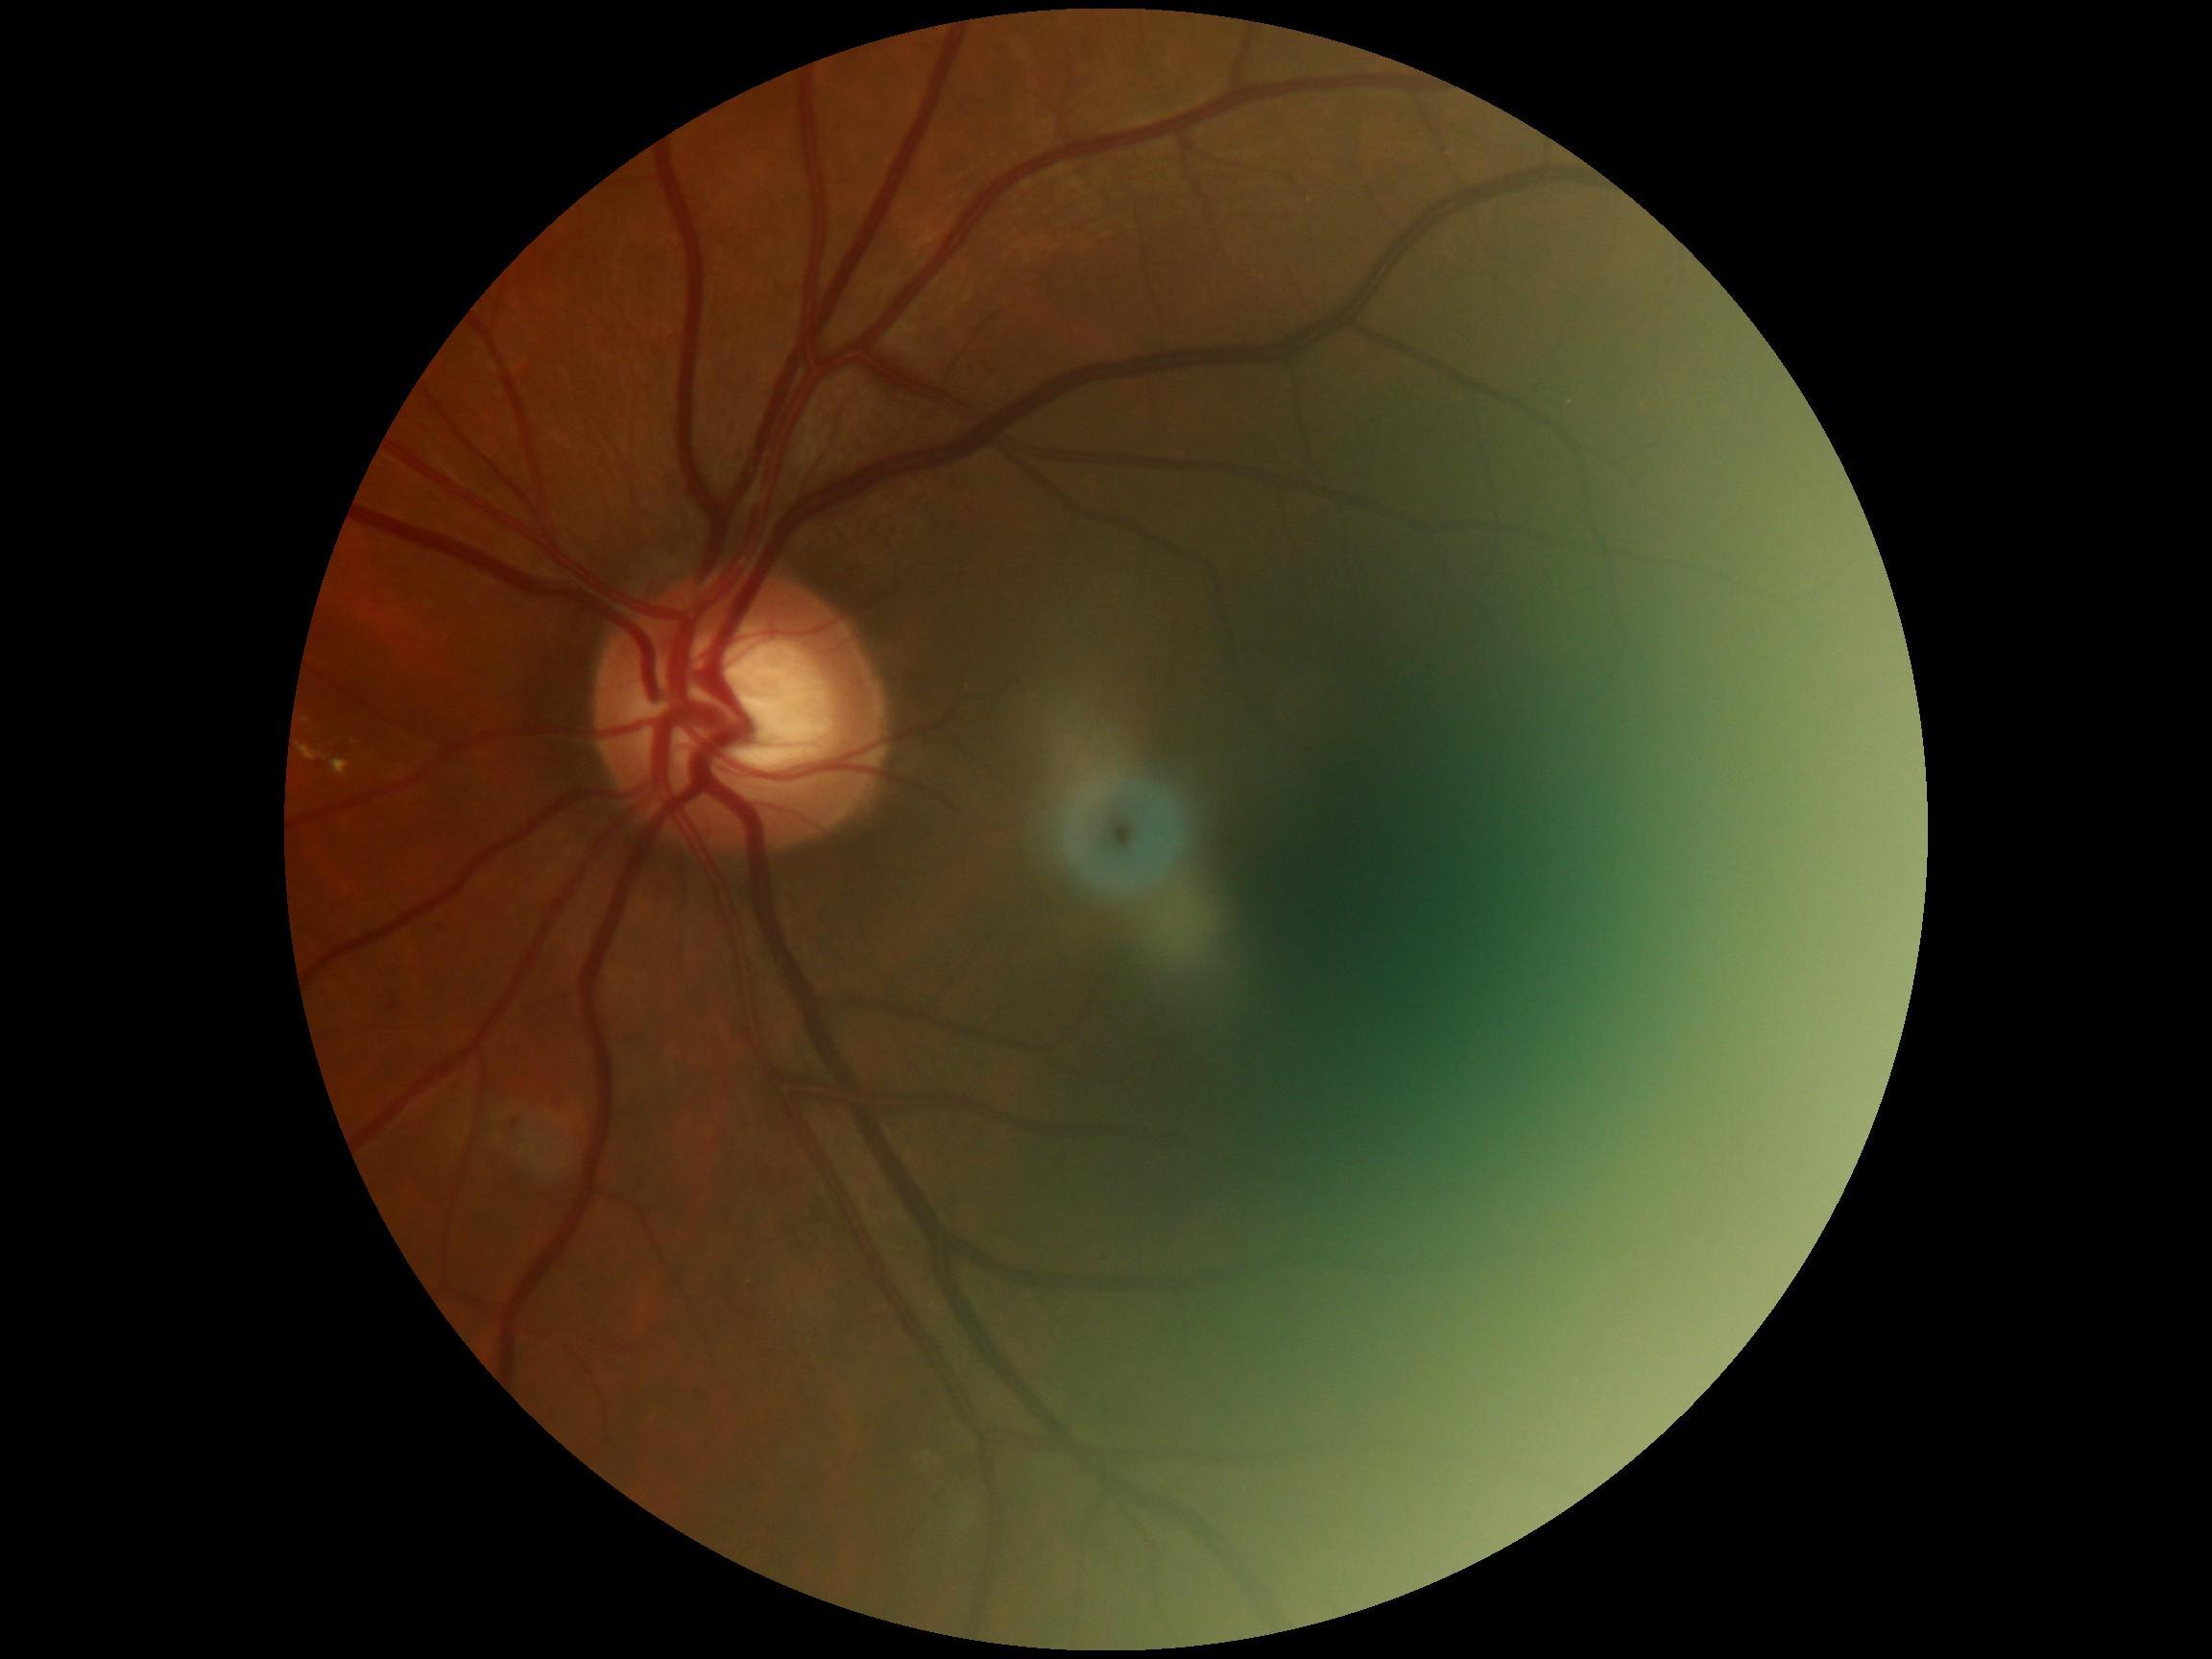 DR stage = moderate non-proliferative diabetic retinopathy (grade 2).